45° FOV · color fundus image.
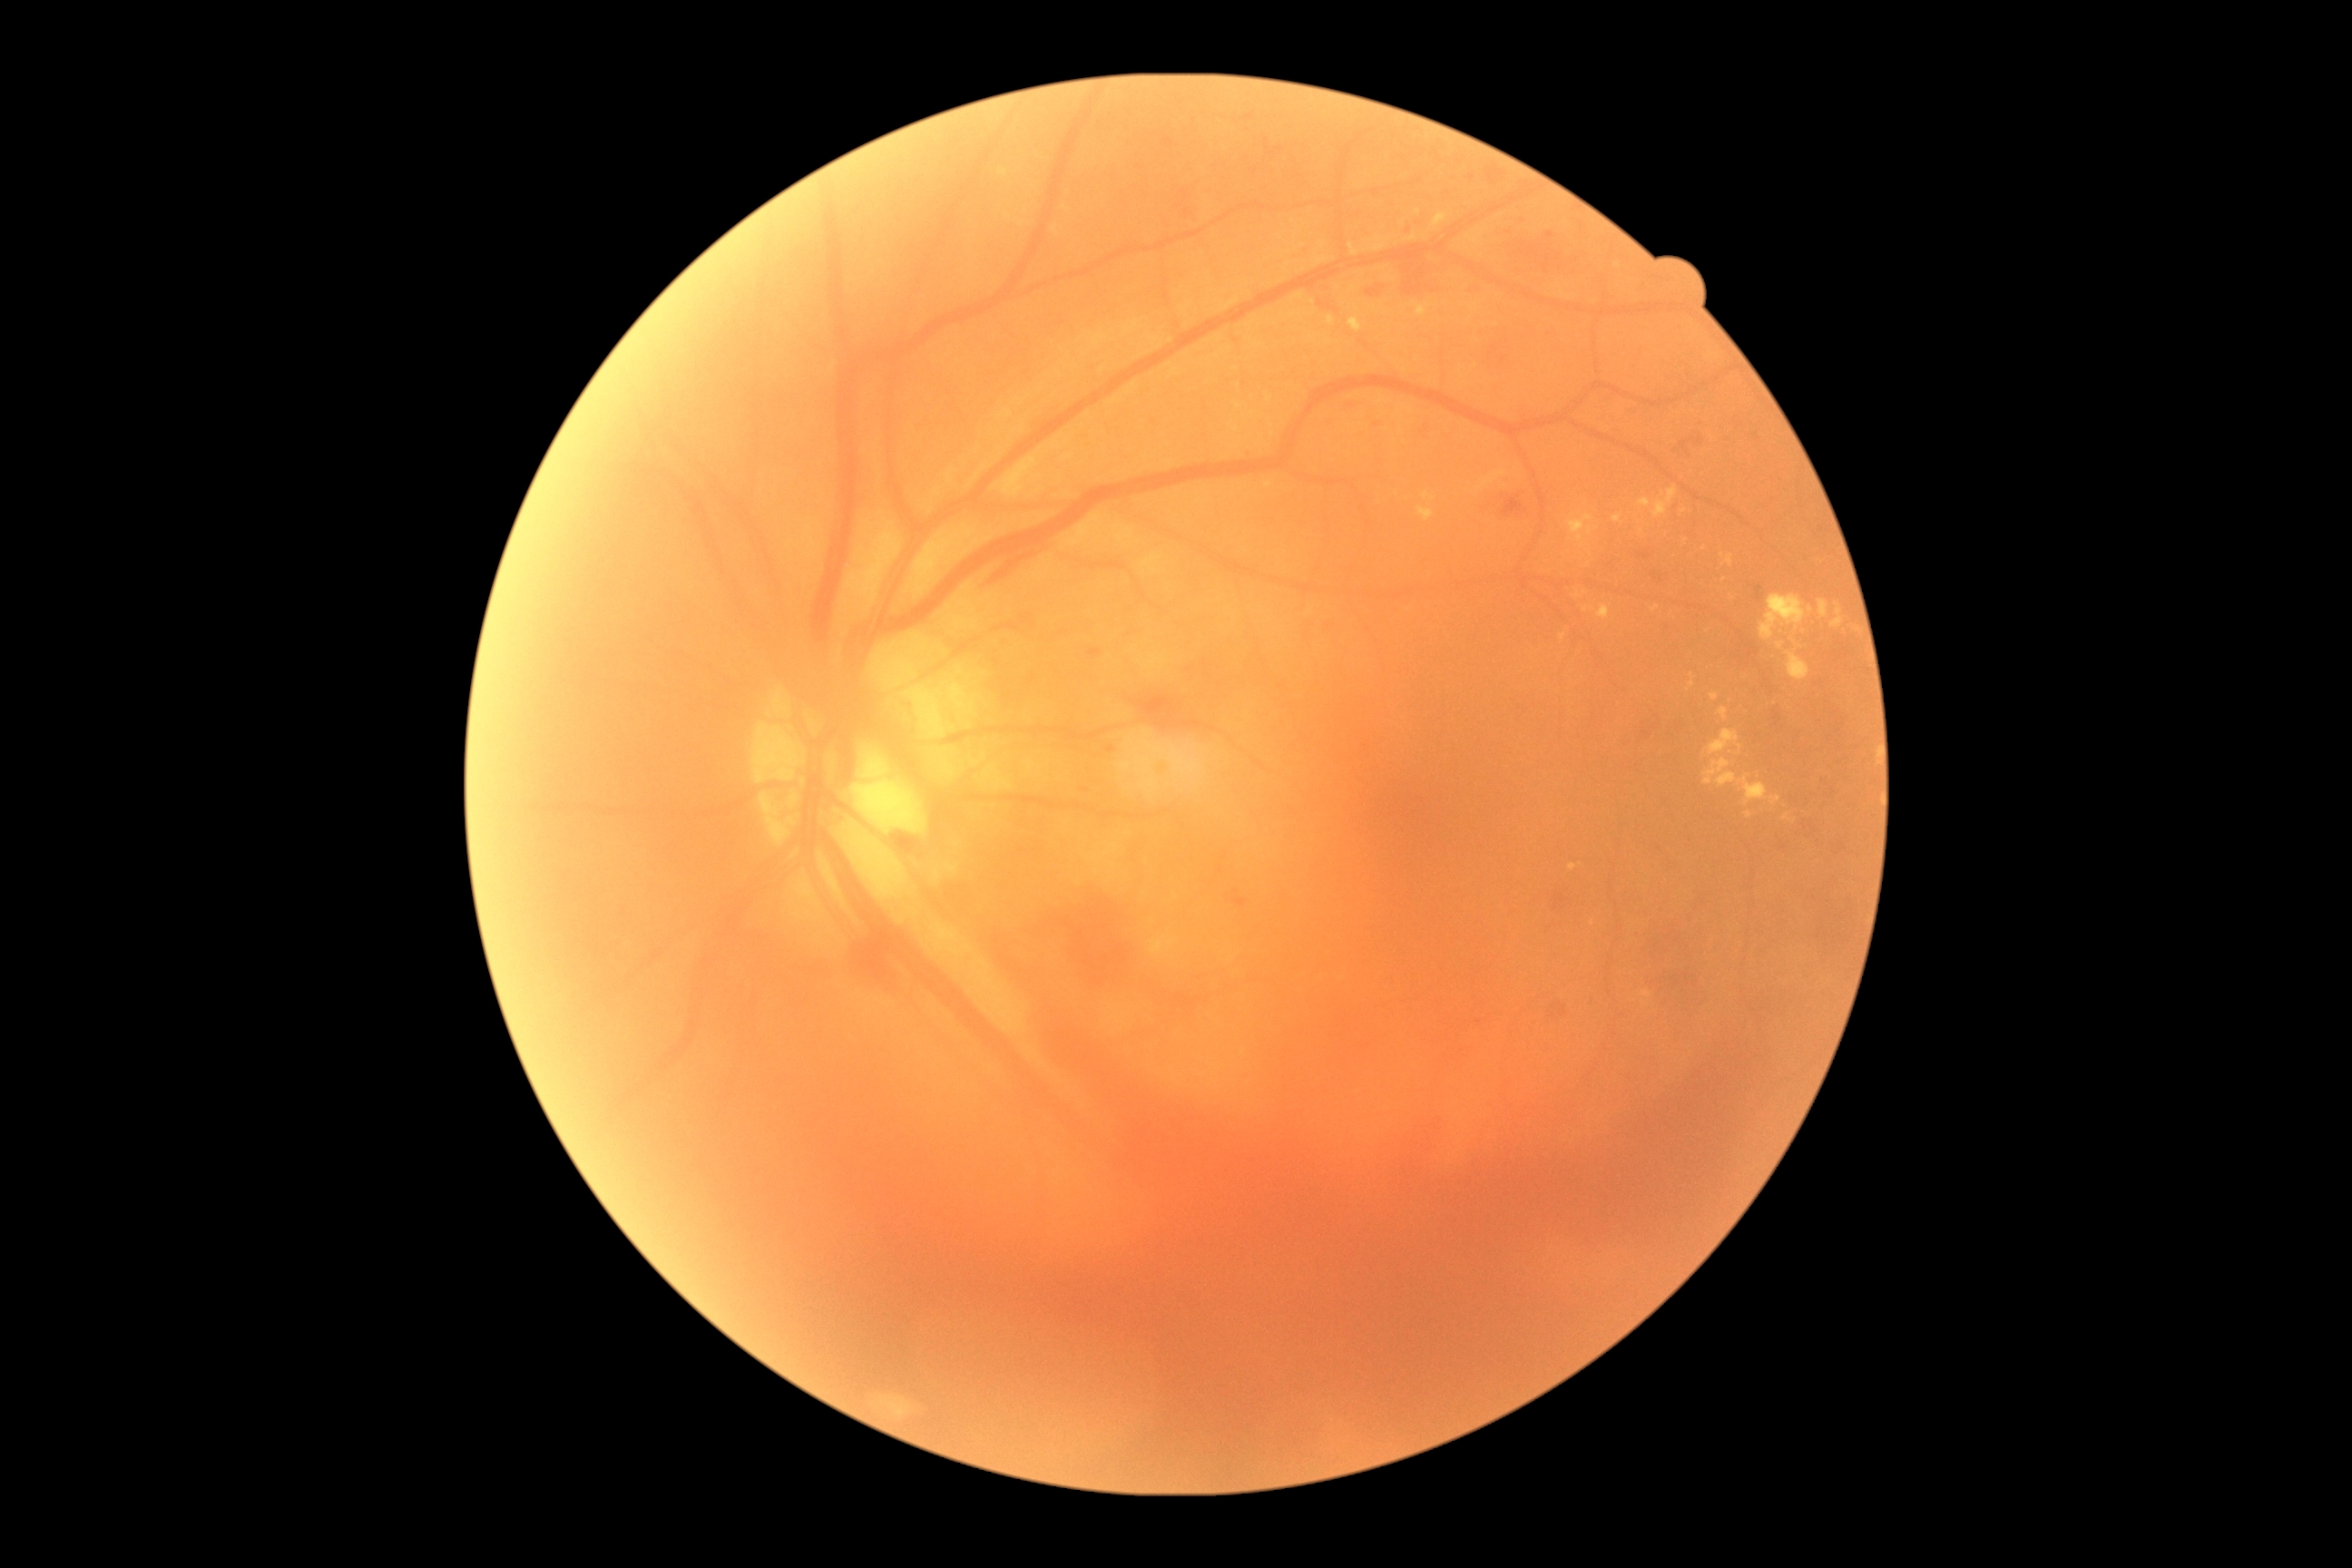

Diabetic retinopathy grade: proliferative diabetic retinopathy (4).
Hard exudates include {"x1": 1406, "y1": 233, "x2": 1418, "y2": 242}; {"x1": 1709, "y1": 730, "x2": 1743, "y2": 756}; {"x1": 1690, "y1": 672, "x2": 1696, "y2": 680}; {"x1": 1727, "y1": 554, "x2": 1734, "y2": 567}; {"x1": 1587, "y1": 527, "x2": 1598, "y2": 536}; {"x1": 1328, "y1": 317, "x2": 1335, "y2": 326}; {"x1": 1418, "y1": 507, "x2": 1435, "y2": 522}; {"x1": 1819, "y1": 600, "x2": 1828, "y2": 618}; {"x1": 1747, "y1": 810, "x2": 1752, "y2": 819}; {"x1": 1787, "y1": 652, "x2": 1810, "y2": 681}.
Small hard exudates near <pt>1482,235</pt>; <pt>1586,609</pt>; <pt>1426,496</pt>; <pt>1810,609</pt>; <pt>1705,549</pt>; <pt>1572,866</pt>.